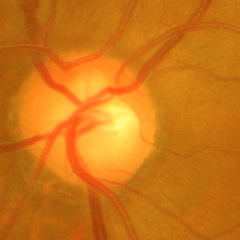 Findings consistent with glaucoma. There is evidence of advanced-stage glaucoma.